Phoenix ICON wide-field infant fundus image.
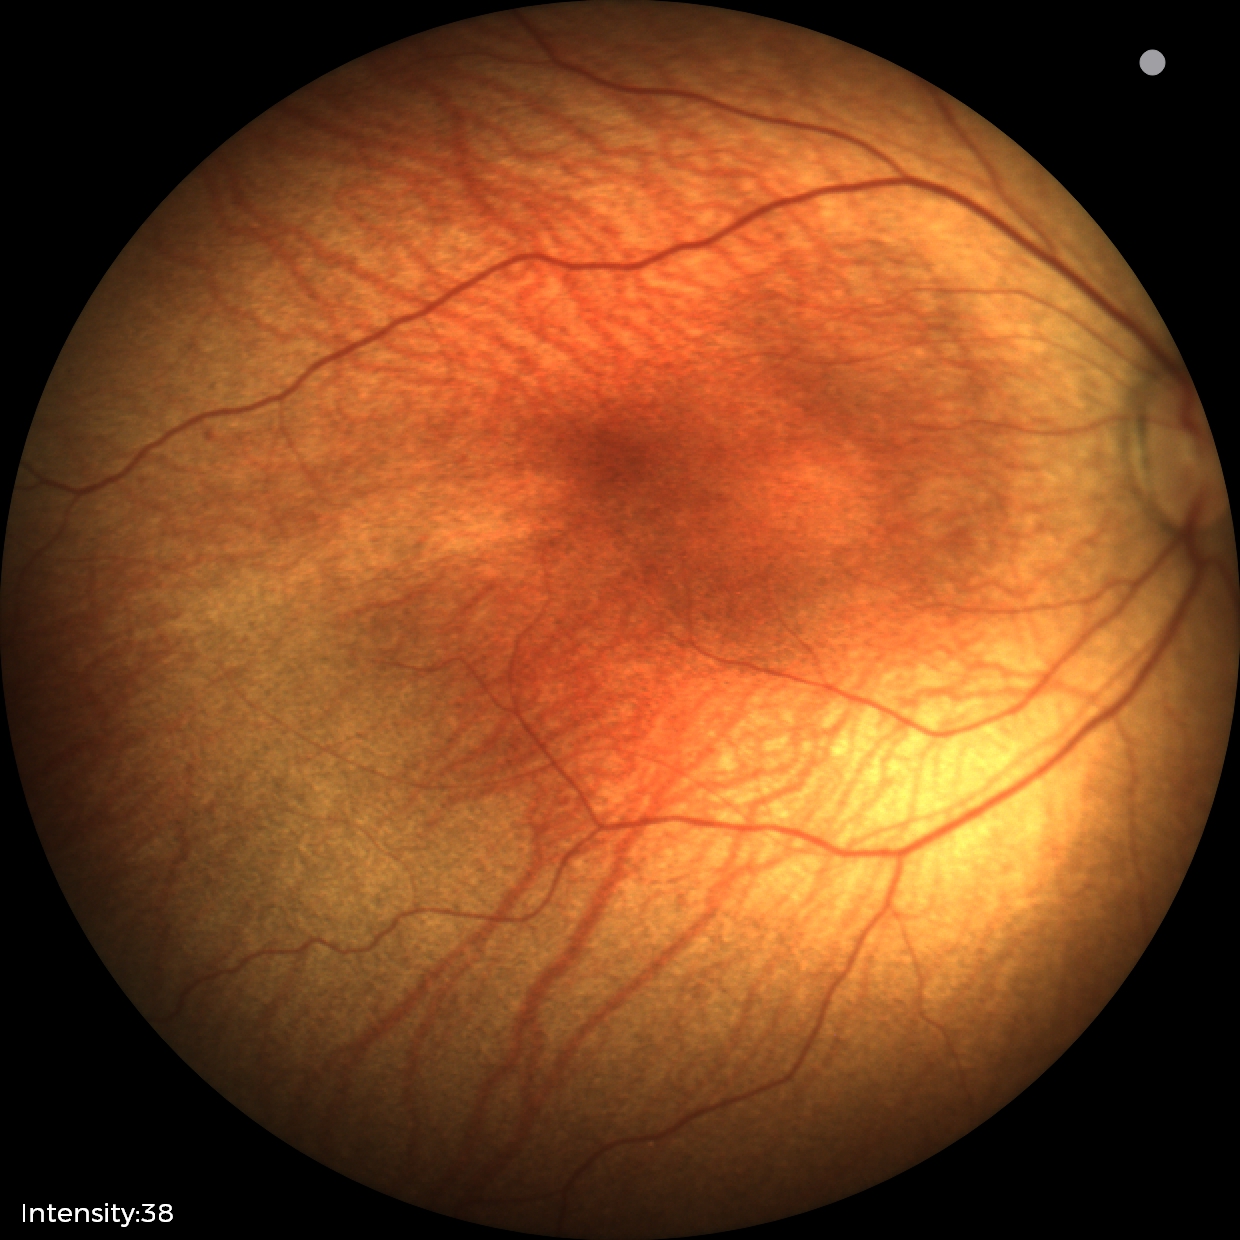
Plus disease absent. From an examination with diagnosis of status post retinopathy of prematurity.